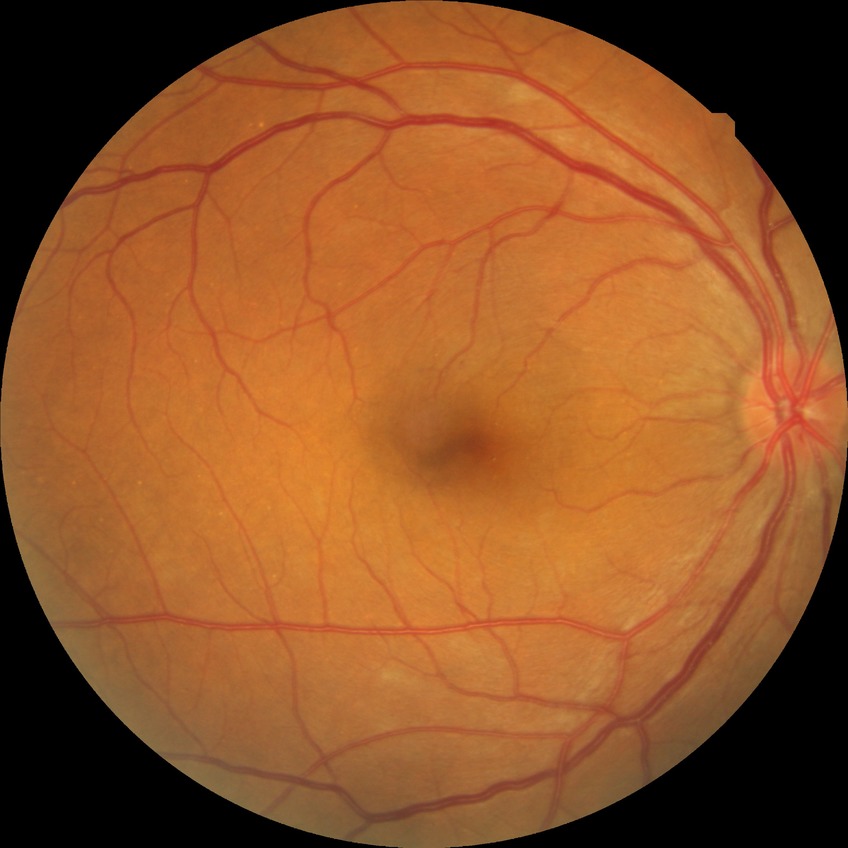
Findings:
- Davis grade: NDR
- DR impression: negative for DR